Portable fundus photograph:
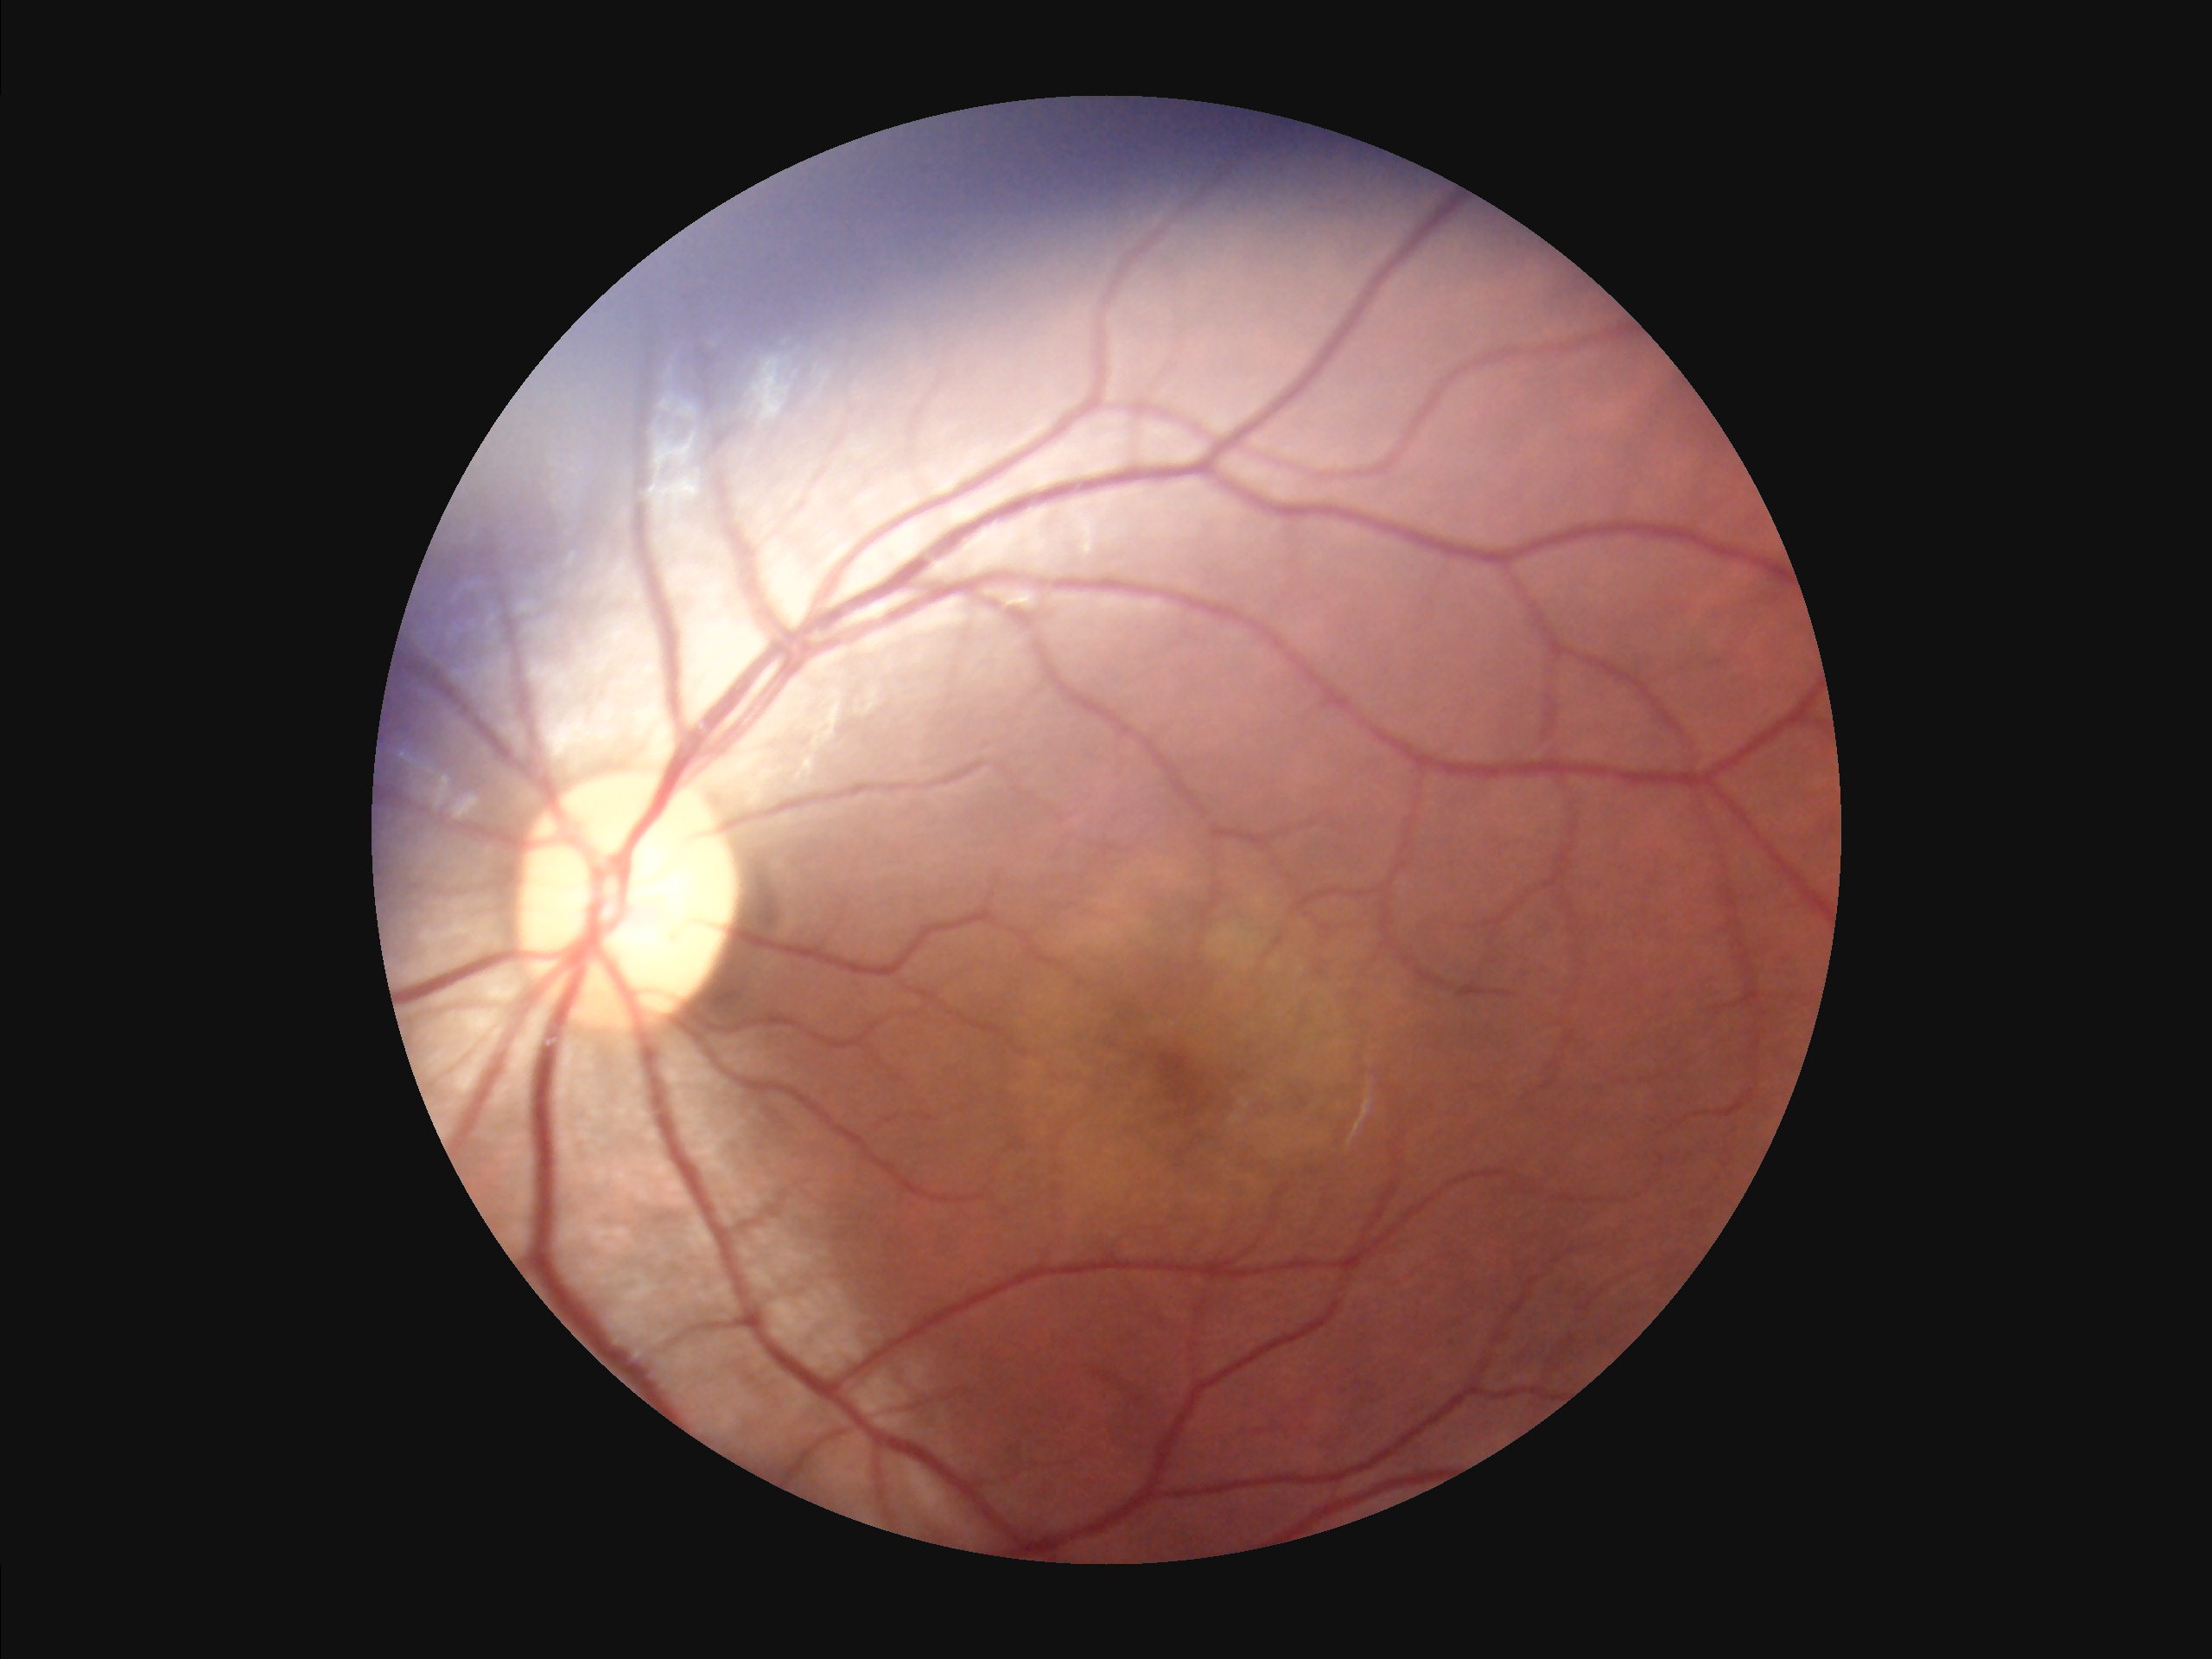

Adequate contrast for distinguishing structures. Illumination is uneven. Image quality is adequate for diagnostic use. Image is sharp throughout the field.